UWF retinal mosaic:
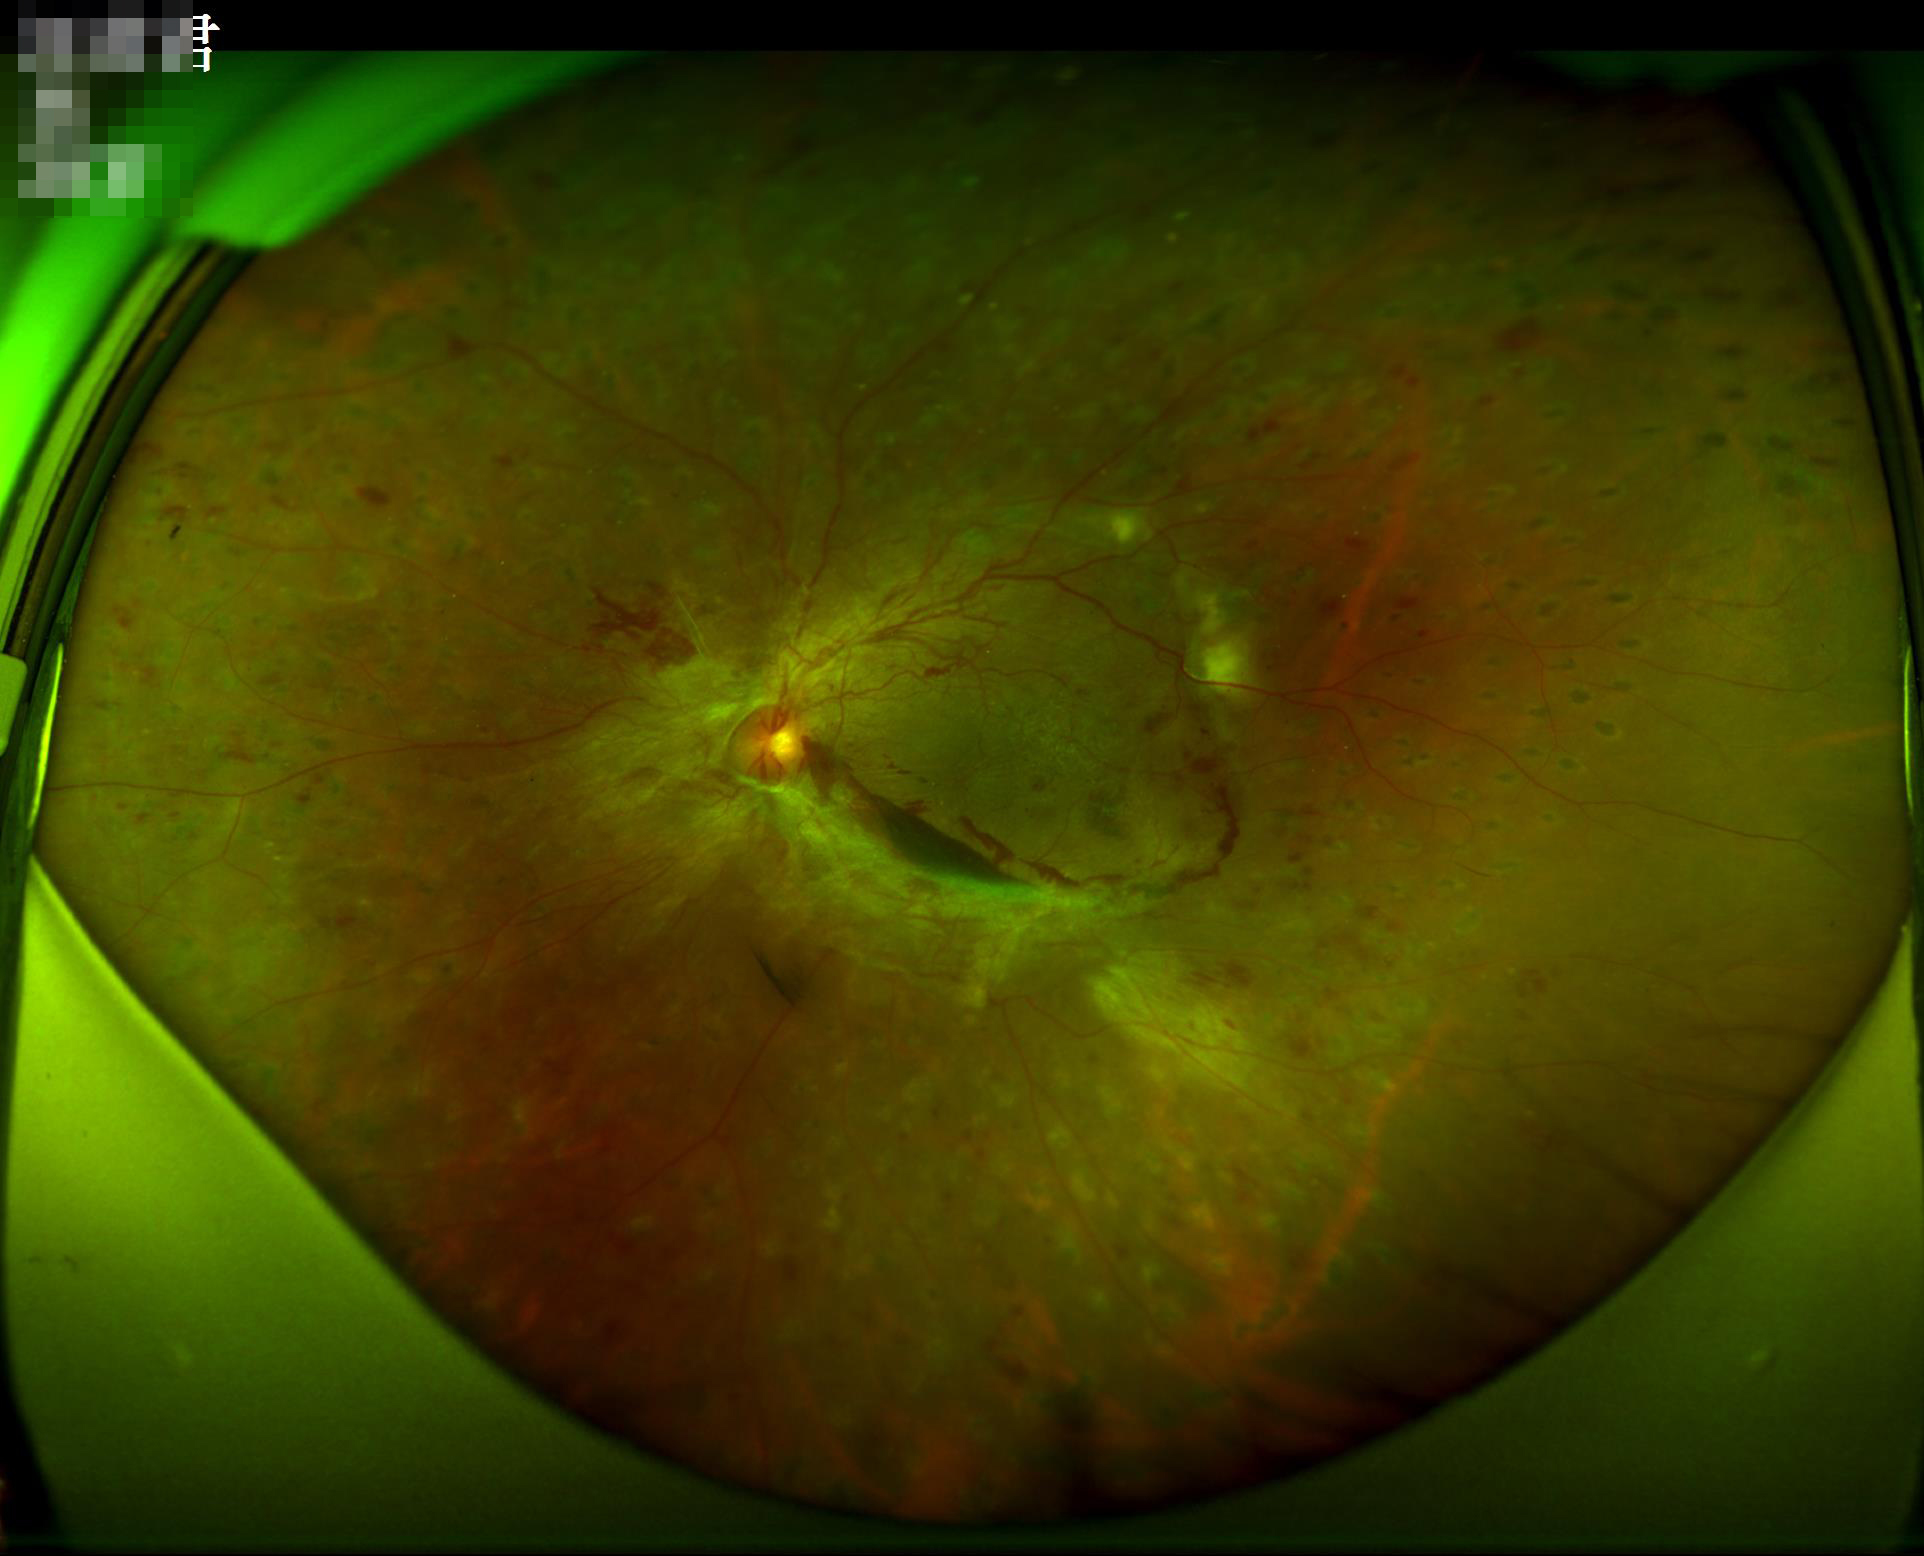 Overall quality is good and the image is gradable. The image is clear. Even illumination with no color cast. Contrast is good.